Davis DR grading:
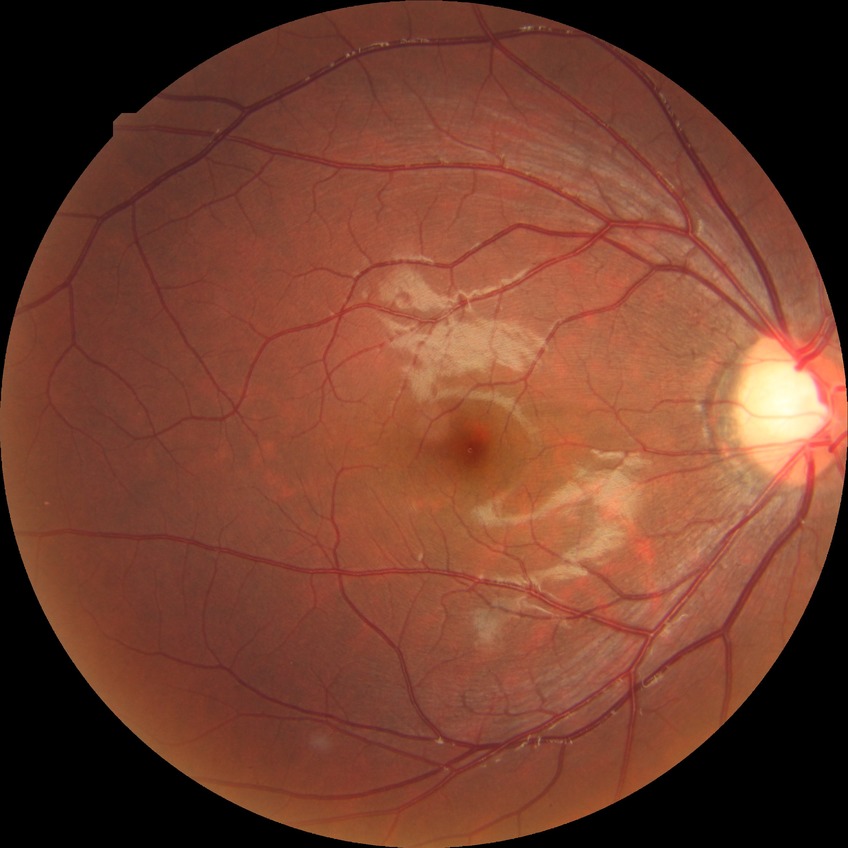
Diabetic retinopathy (DR) is NDR (no diabetic retinopathy).